FOV: 200 degrees:
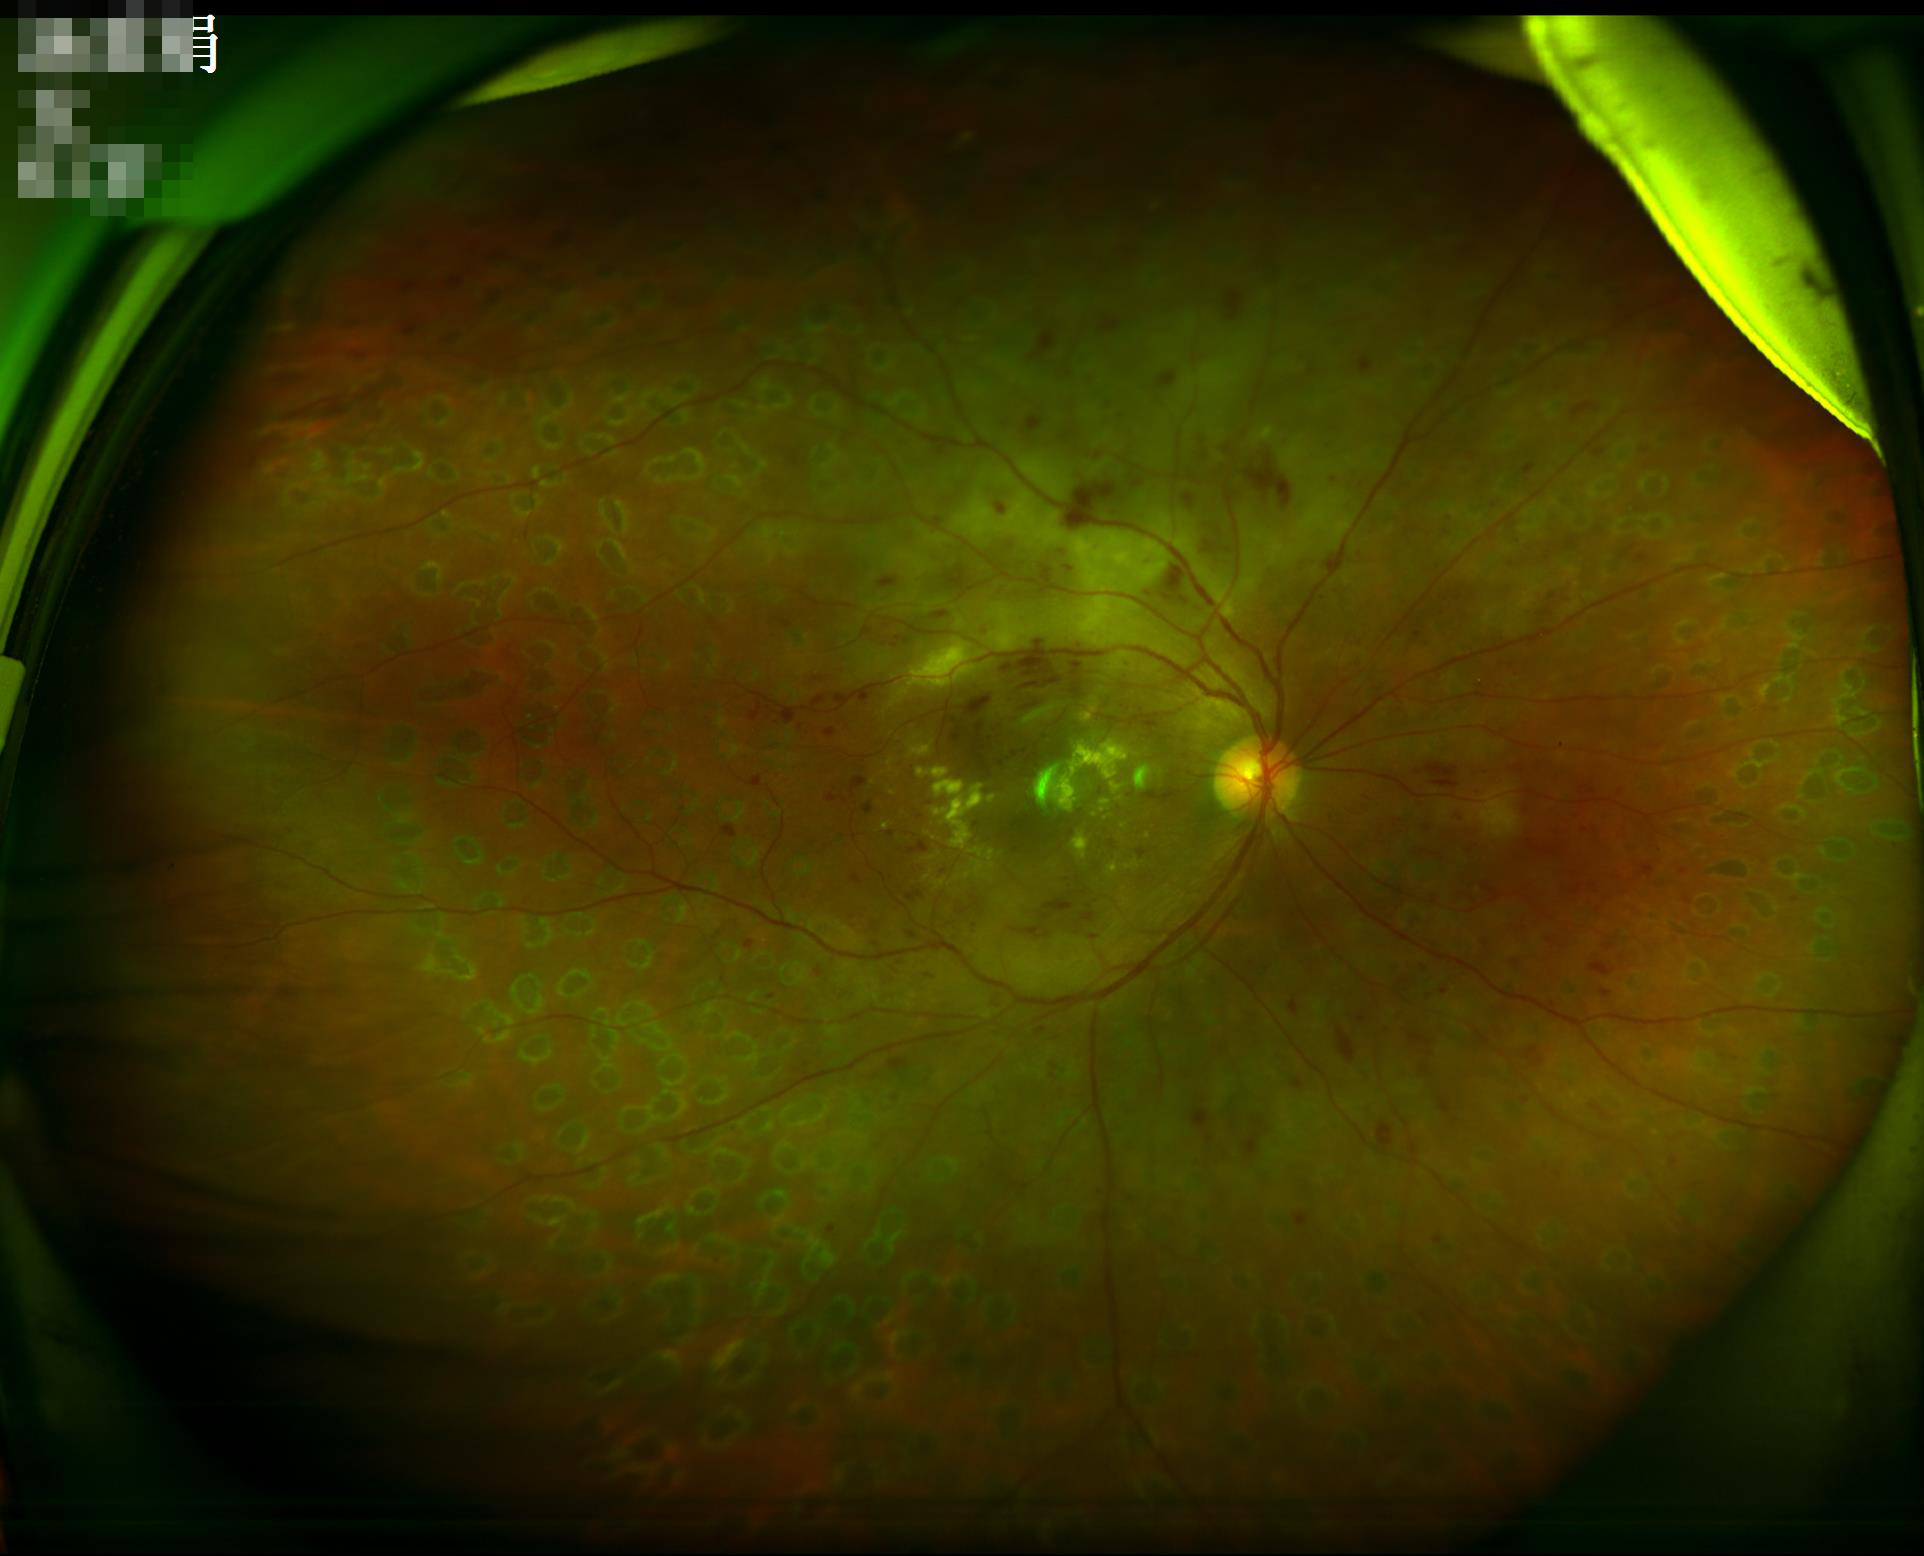 Overall = acceptable
Focus = clear
Contrast = satisfactory